Fundus photo: 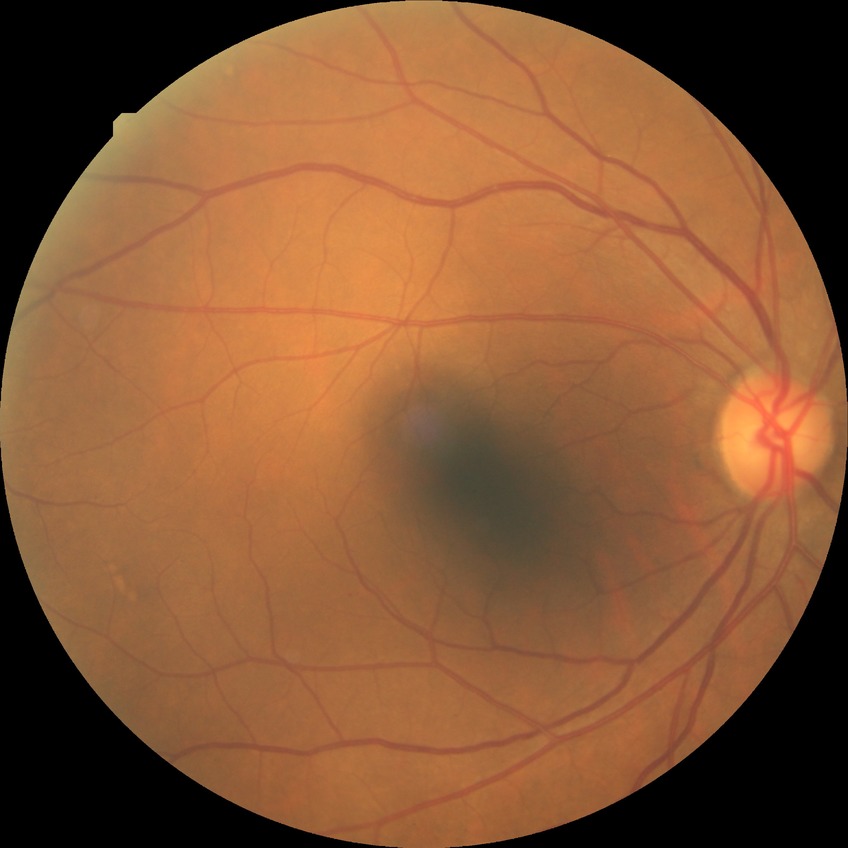

{
  "davis_grade": "NDR (no diabetic retinopathy)"
}